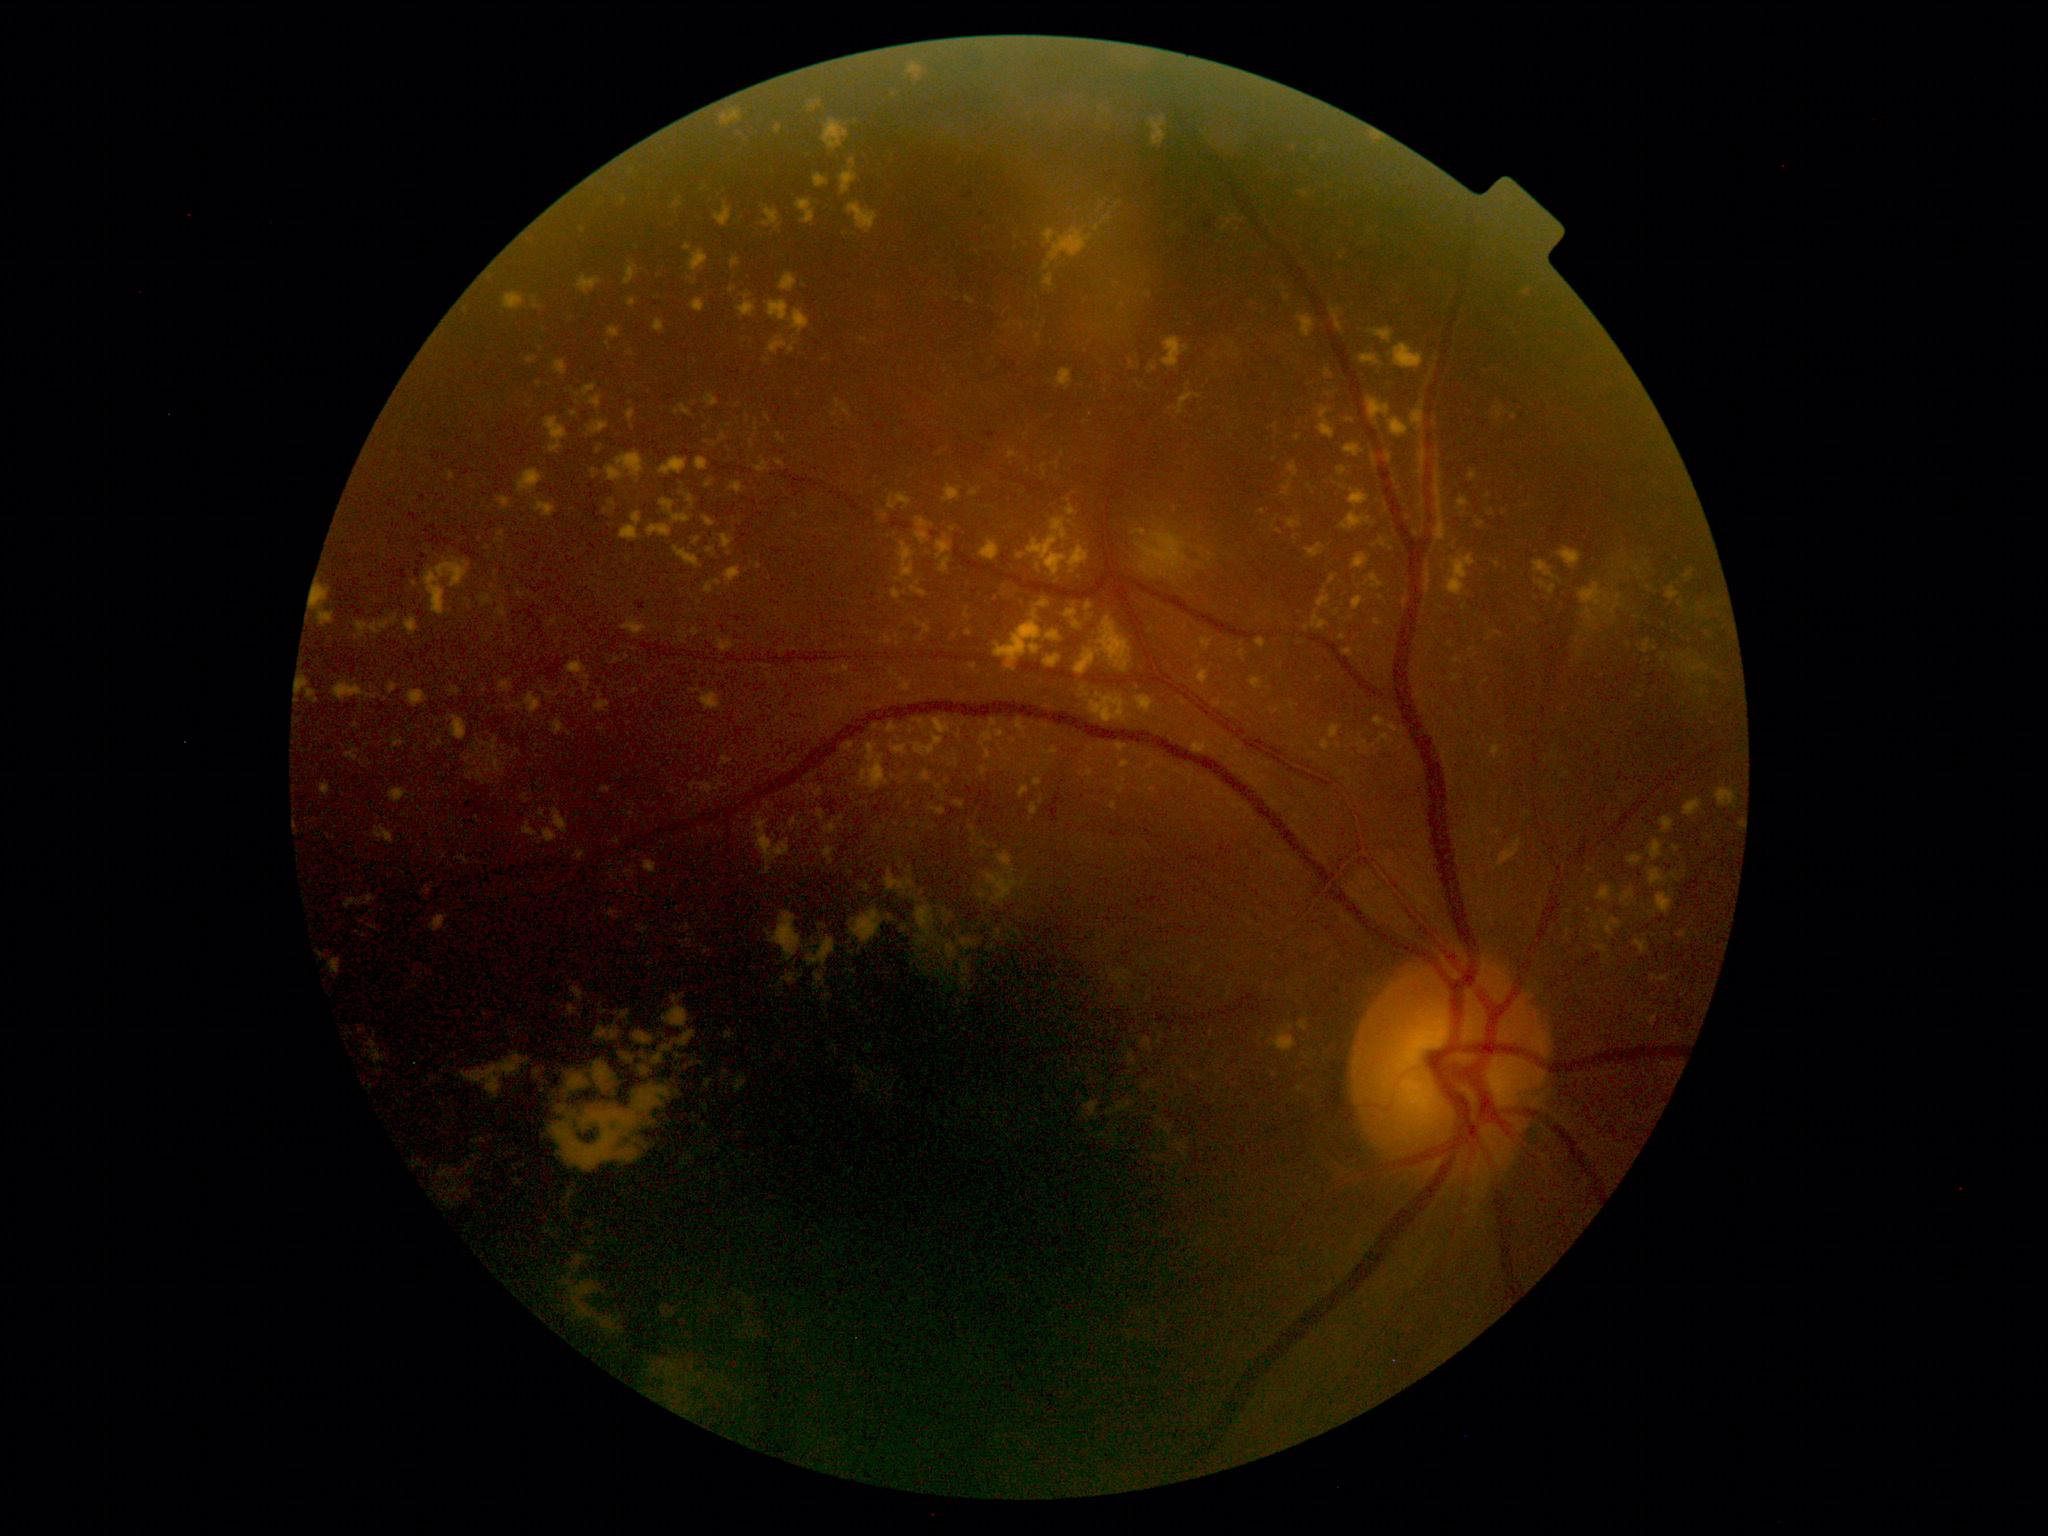 Diabetic retinopathy severity: grade 2.